FOV: 45 degrees · color fundus image — 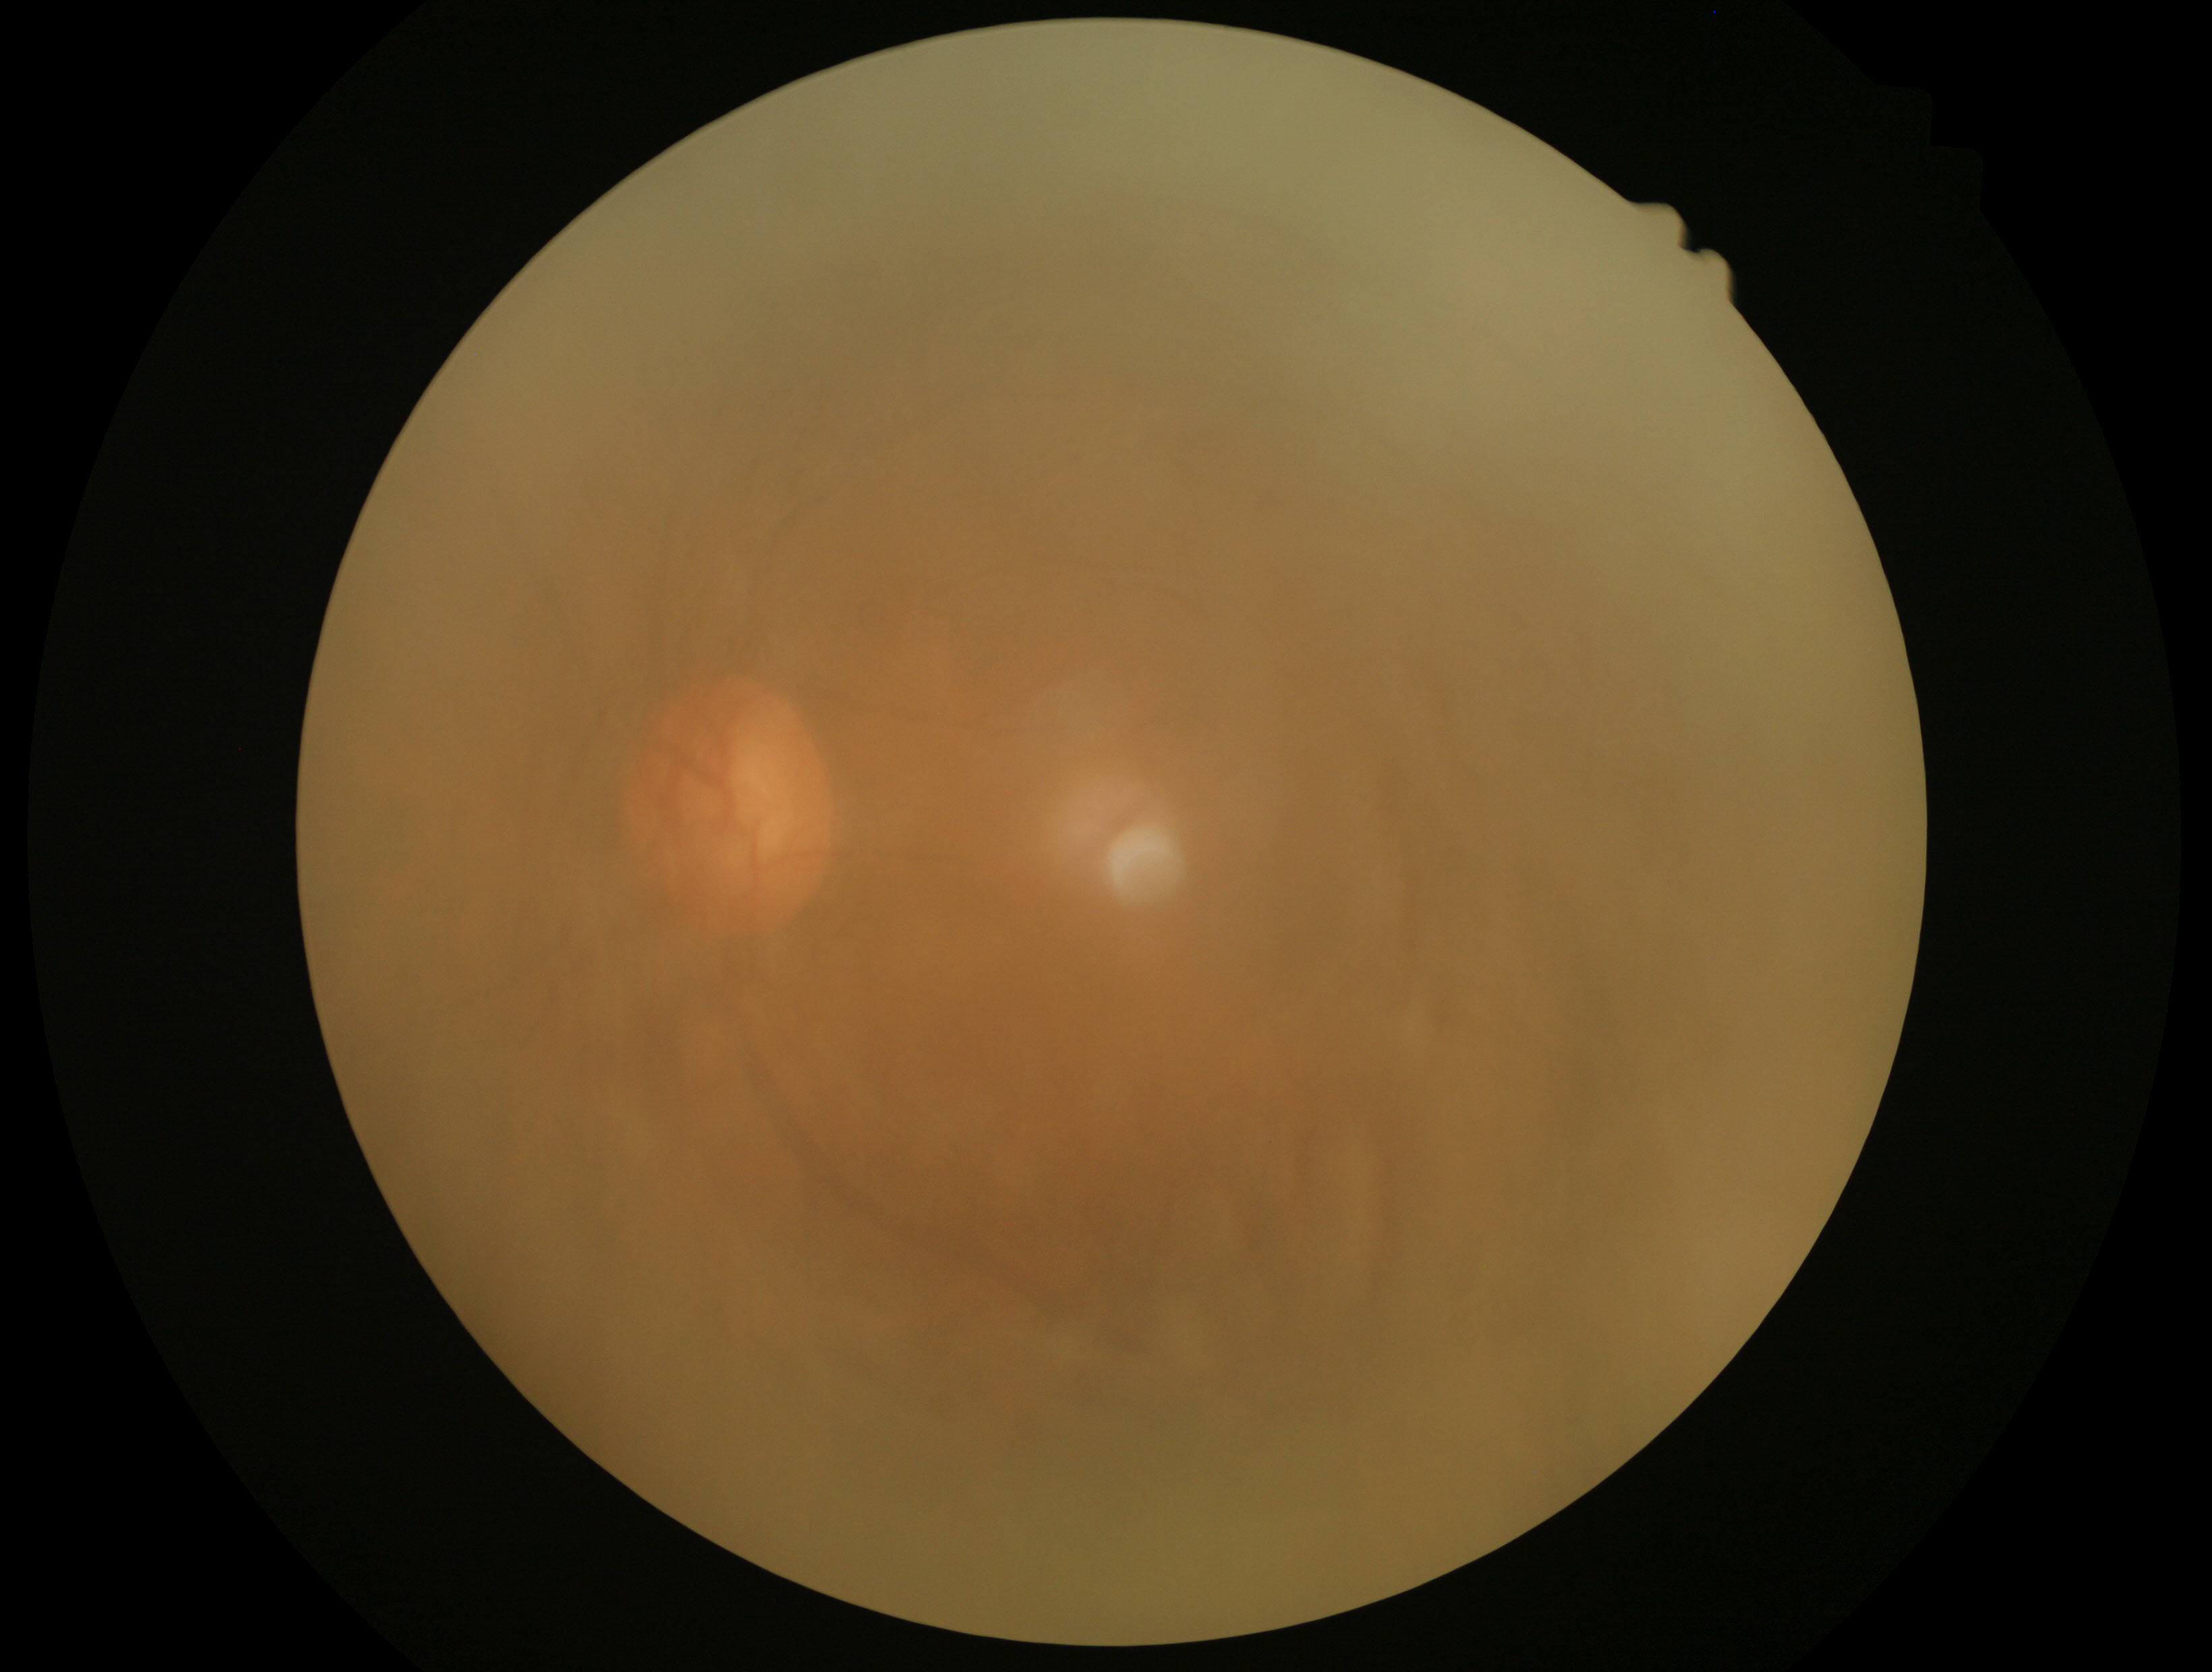

retinopathy grade: ungradable due to poor image quality.